45° FOV; acquired with a NIDEK AFC-230
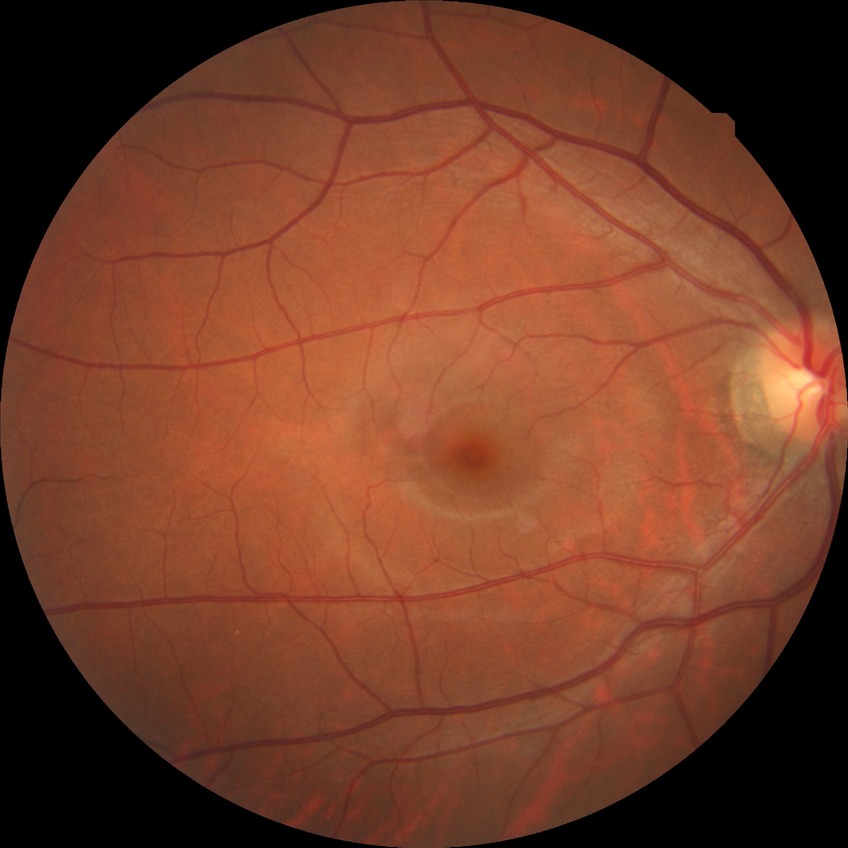

  davis_grade: no diabetic retinopathy (NDR)